45° field of view.
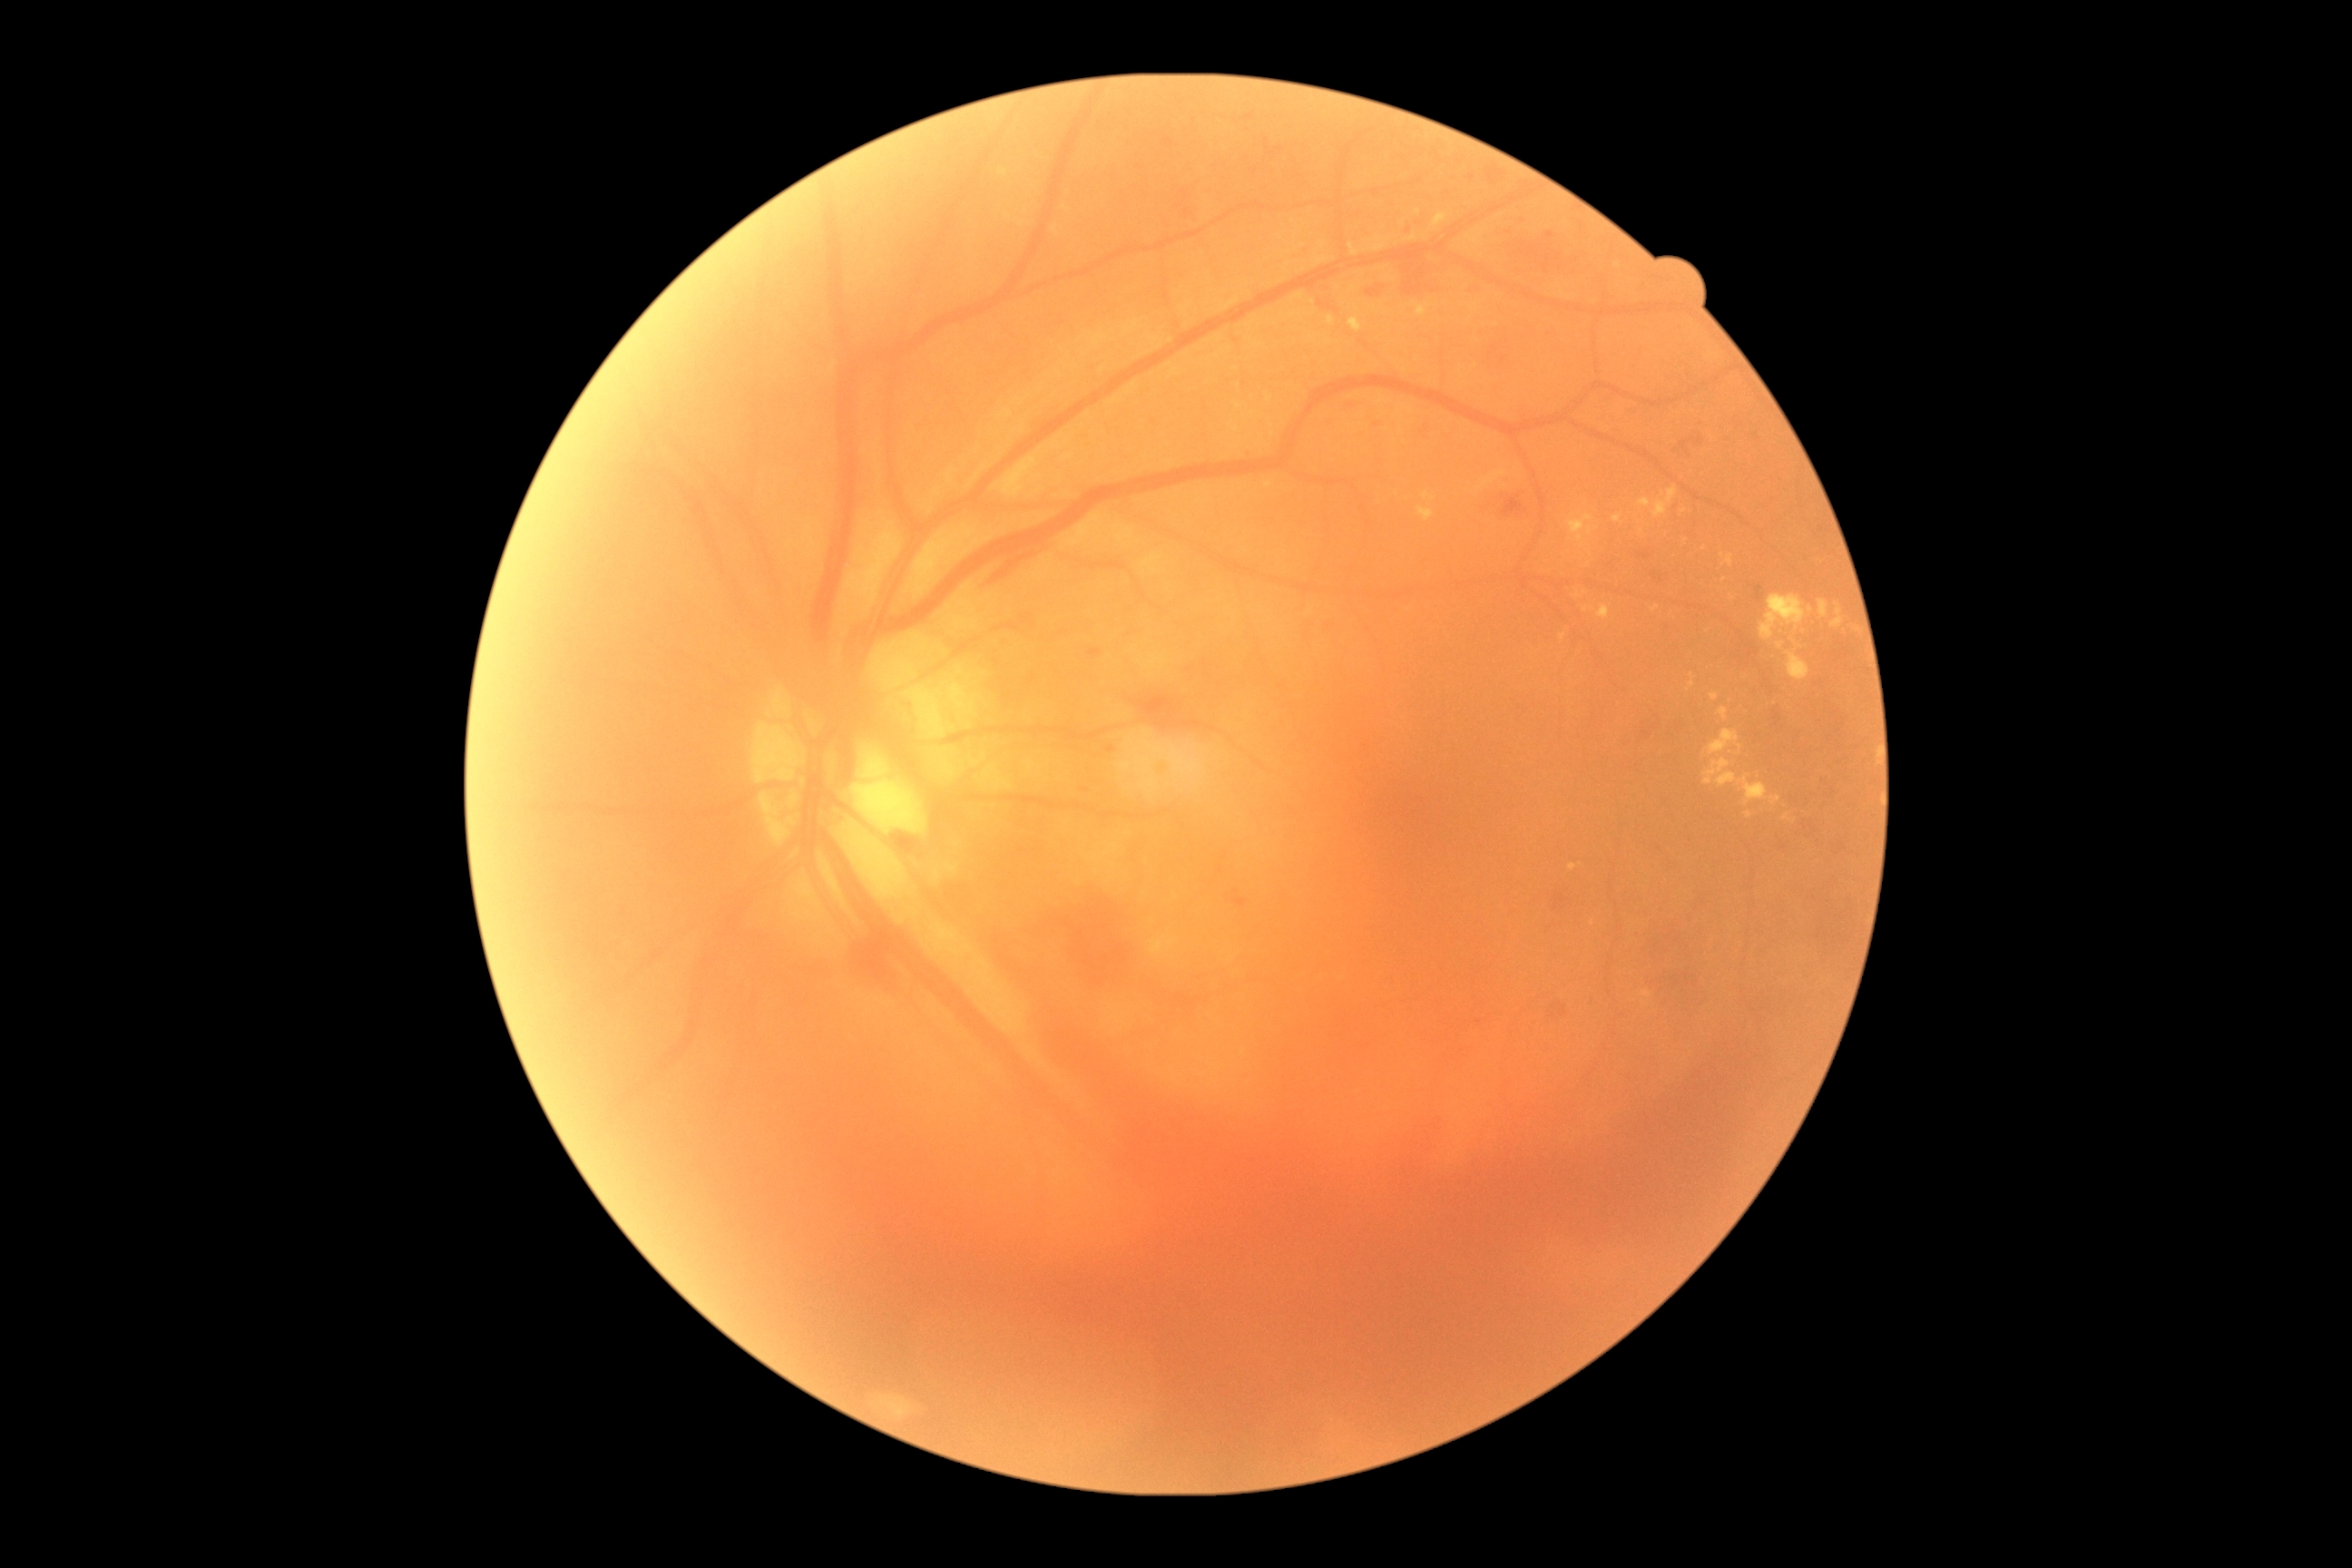

Diabetic retinopathy severity: PDR (grade 4) — neovascularization and/or vitreous/pre-retinal hemorrhage
Representative lesions:
* hard exudates (partial): [1643,992,1651,997]; [1687,681,1696,691]; [1598,605,1611,620]; [1759,594,1805,642]; [1654,487,1678,518]; [1349,317,1364,333]; [1770,796,1781,805]; [1467,235,1478,244]; [1560,634,1567,642]; [1349,244,1358,257]; [1473,304,1478,313]
* Small hard exudates approximately at x=1663, y=494; x=1418, y=212; x=1722, y=555; x=1796, y=643; x=1404, y=224; x=1433, y=499
* hemorrhages (partial): [1756,587,1763,600]; [1019,888,1141,994]; [1504,496,1524,516]; [1651,571,1665,589]; [1643,553,1654,558]; [1654,930,1700,1015]; [1366,286,1382,299]; [1549,1004,1562,1015]; [988,551,1035,585]; [1132,696,1202,732]
* Small hemorrhages approximately at x=1778, y=717